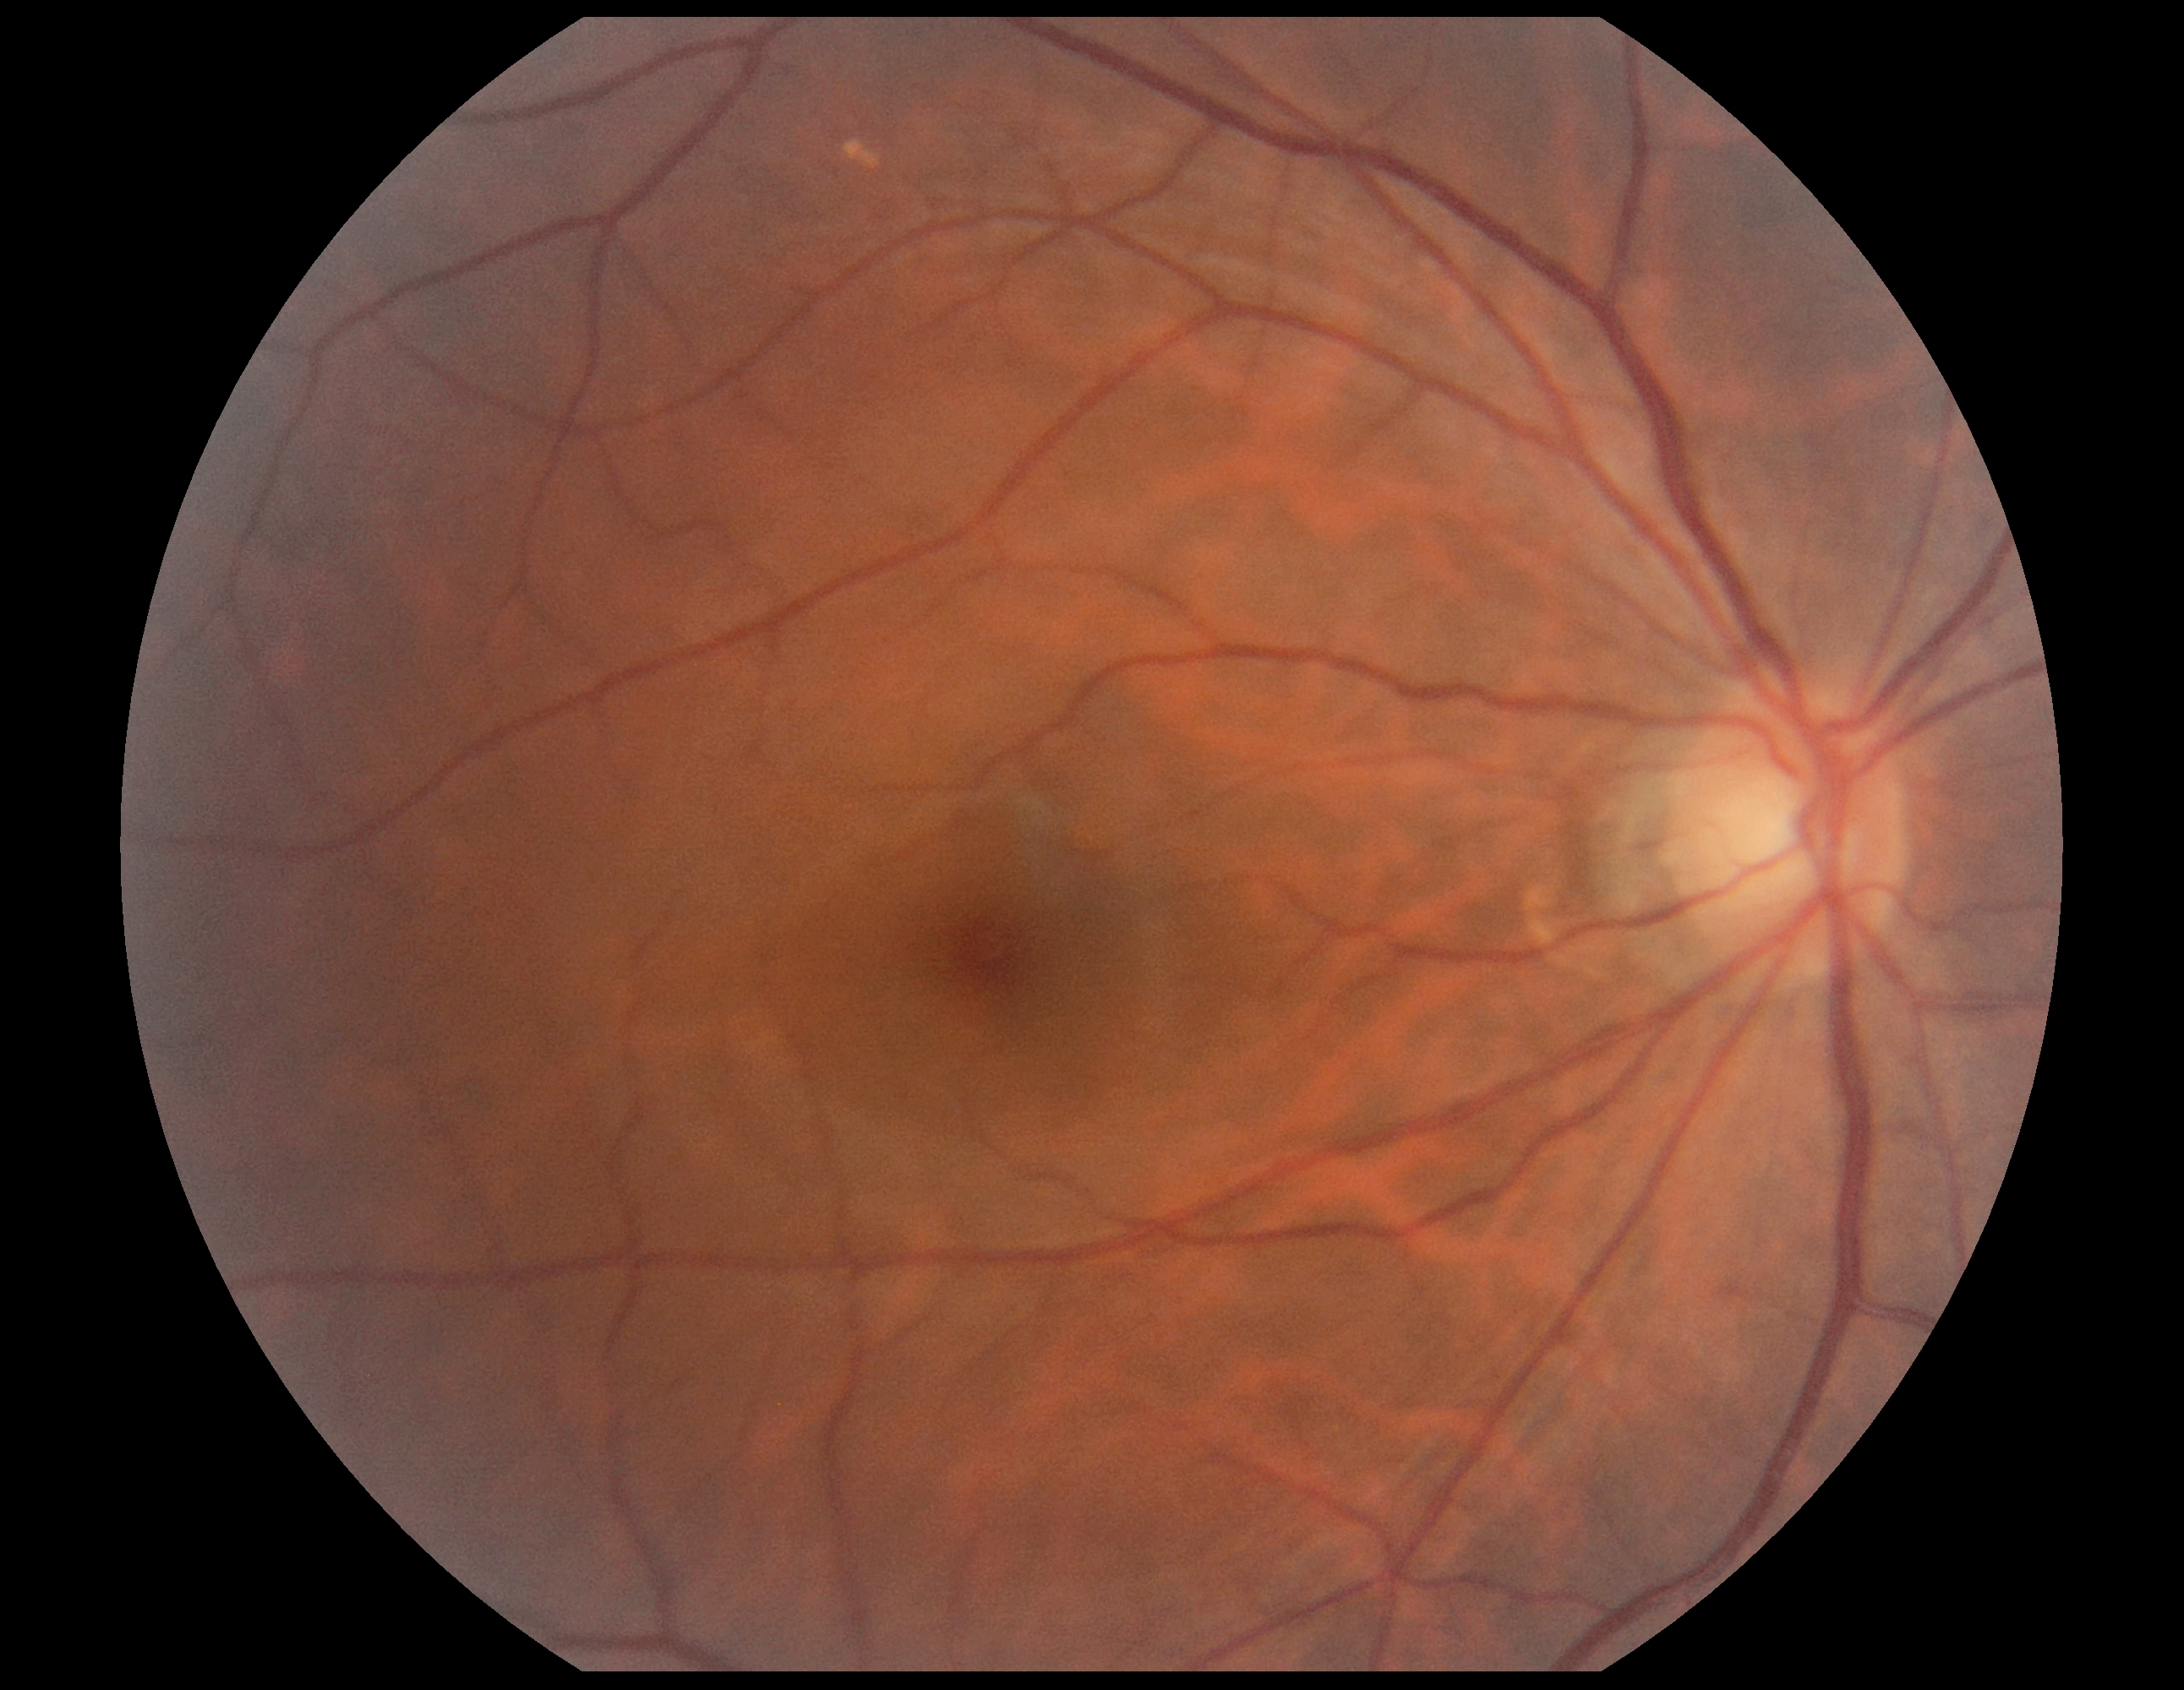

No signs of diabetic retinopathy. DR: grade 0 (no apparent retinopathy) — no visible signs of diabetic retinopathy.